Nonmydriatic fundus photograph — 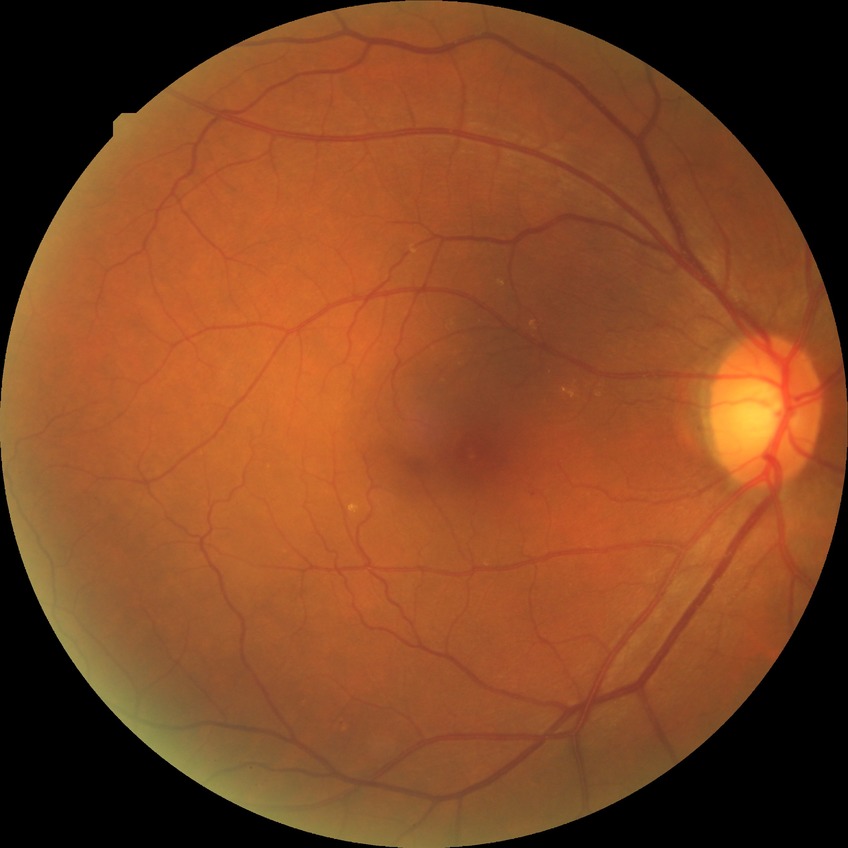 Diabetic retinopathy (DR): simple diabetic retinopathy (SDR).